Acquired with a NIDEK AFC-230; modified Davis grading; 848x848.
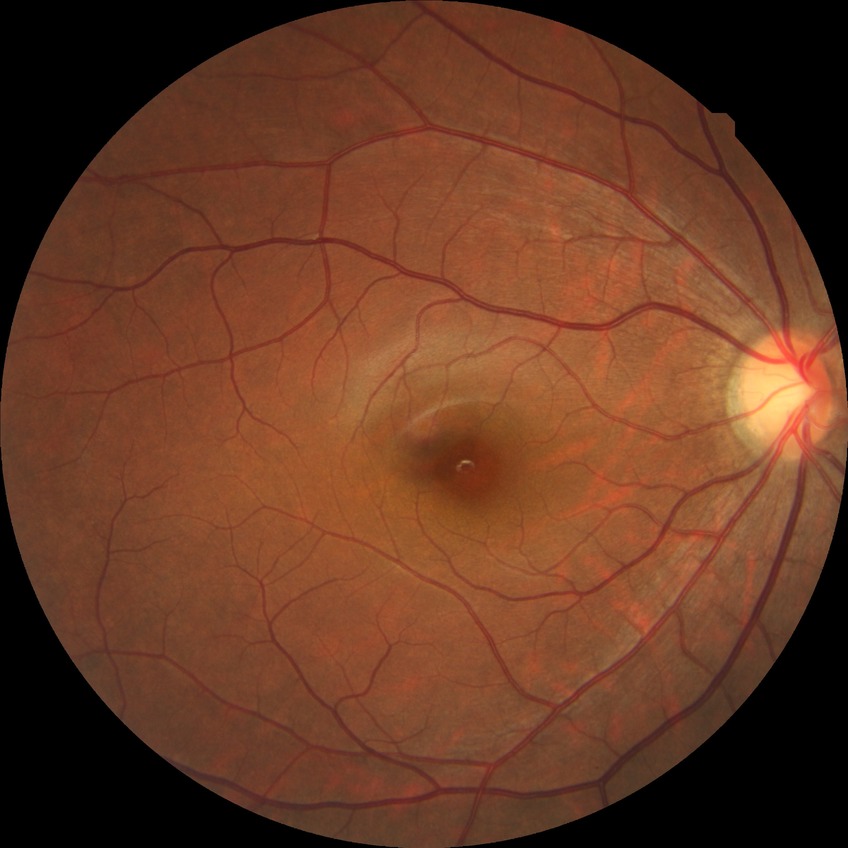

diabetic retinopathy (DR)=NDR (no diabetic retinopathy).